240x240px · non-mydriatic · acquired with a Nidek AFC-330: 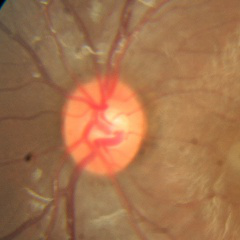

Q: Is glaucoma present?
A: No — no glaucomatous findings.